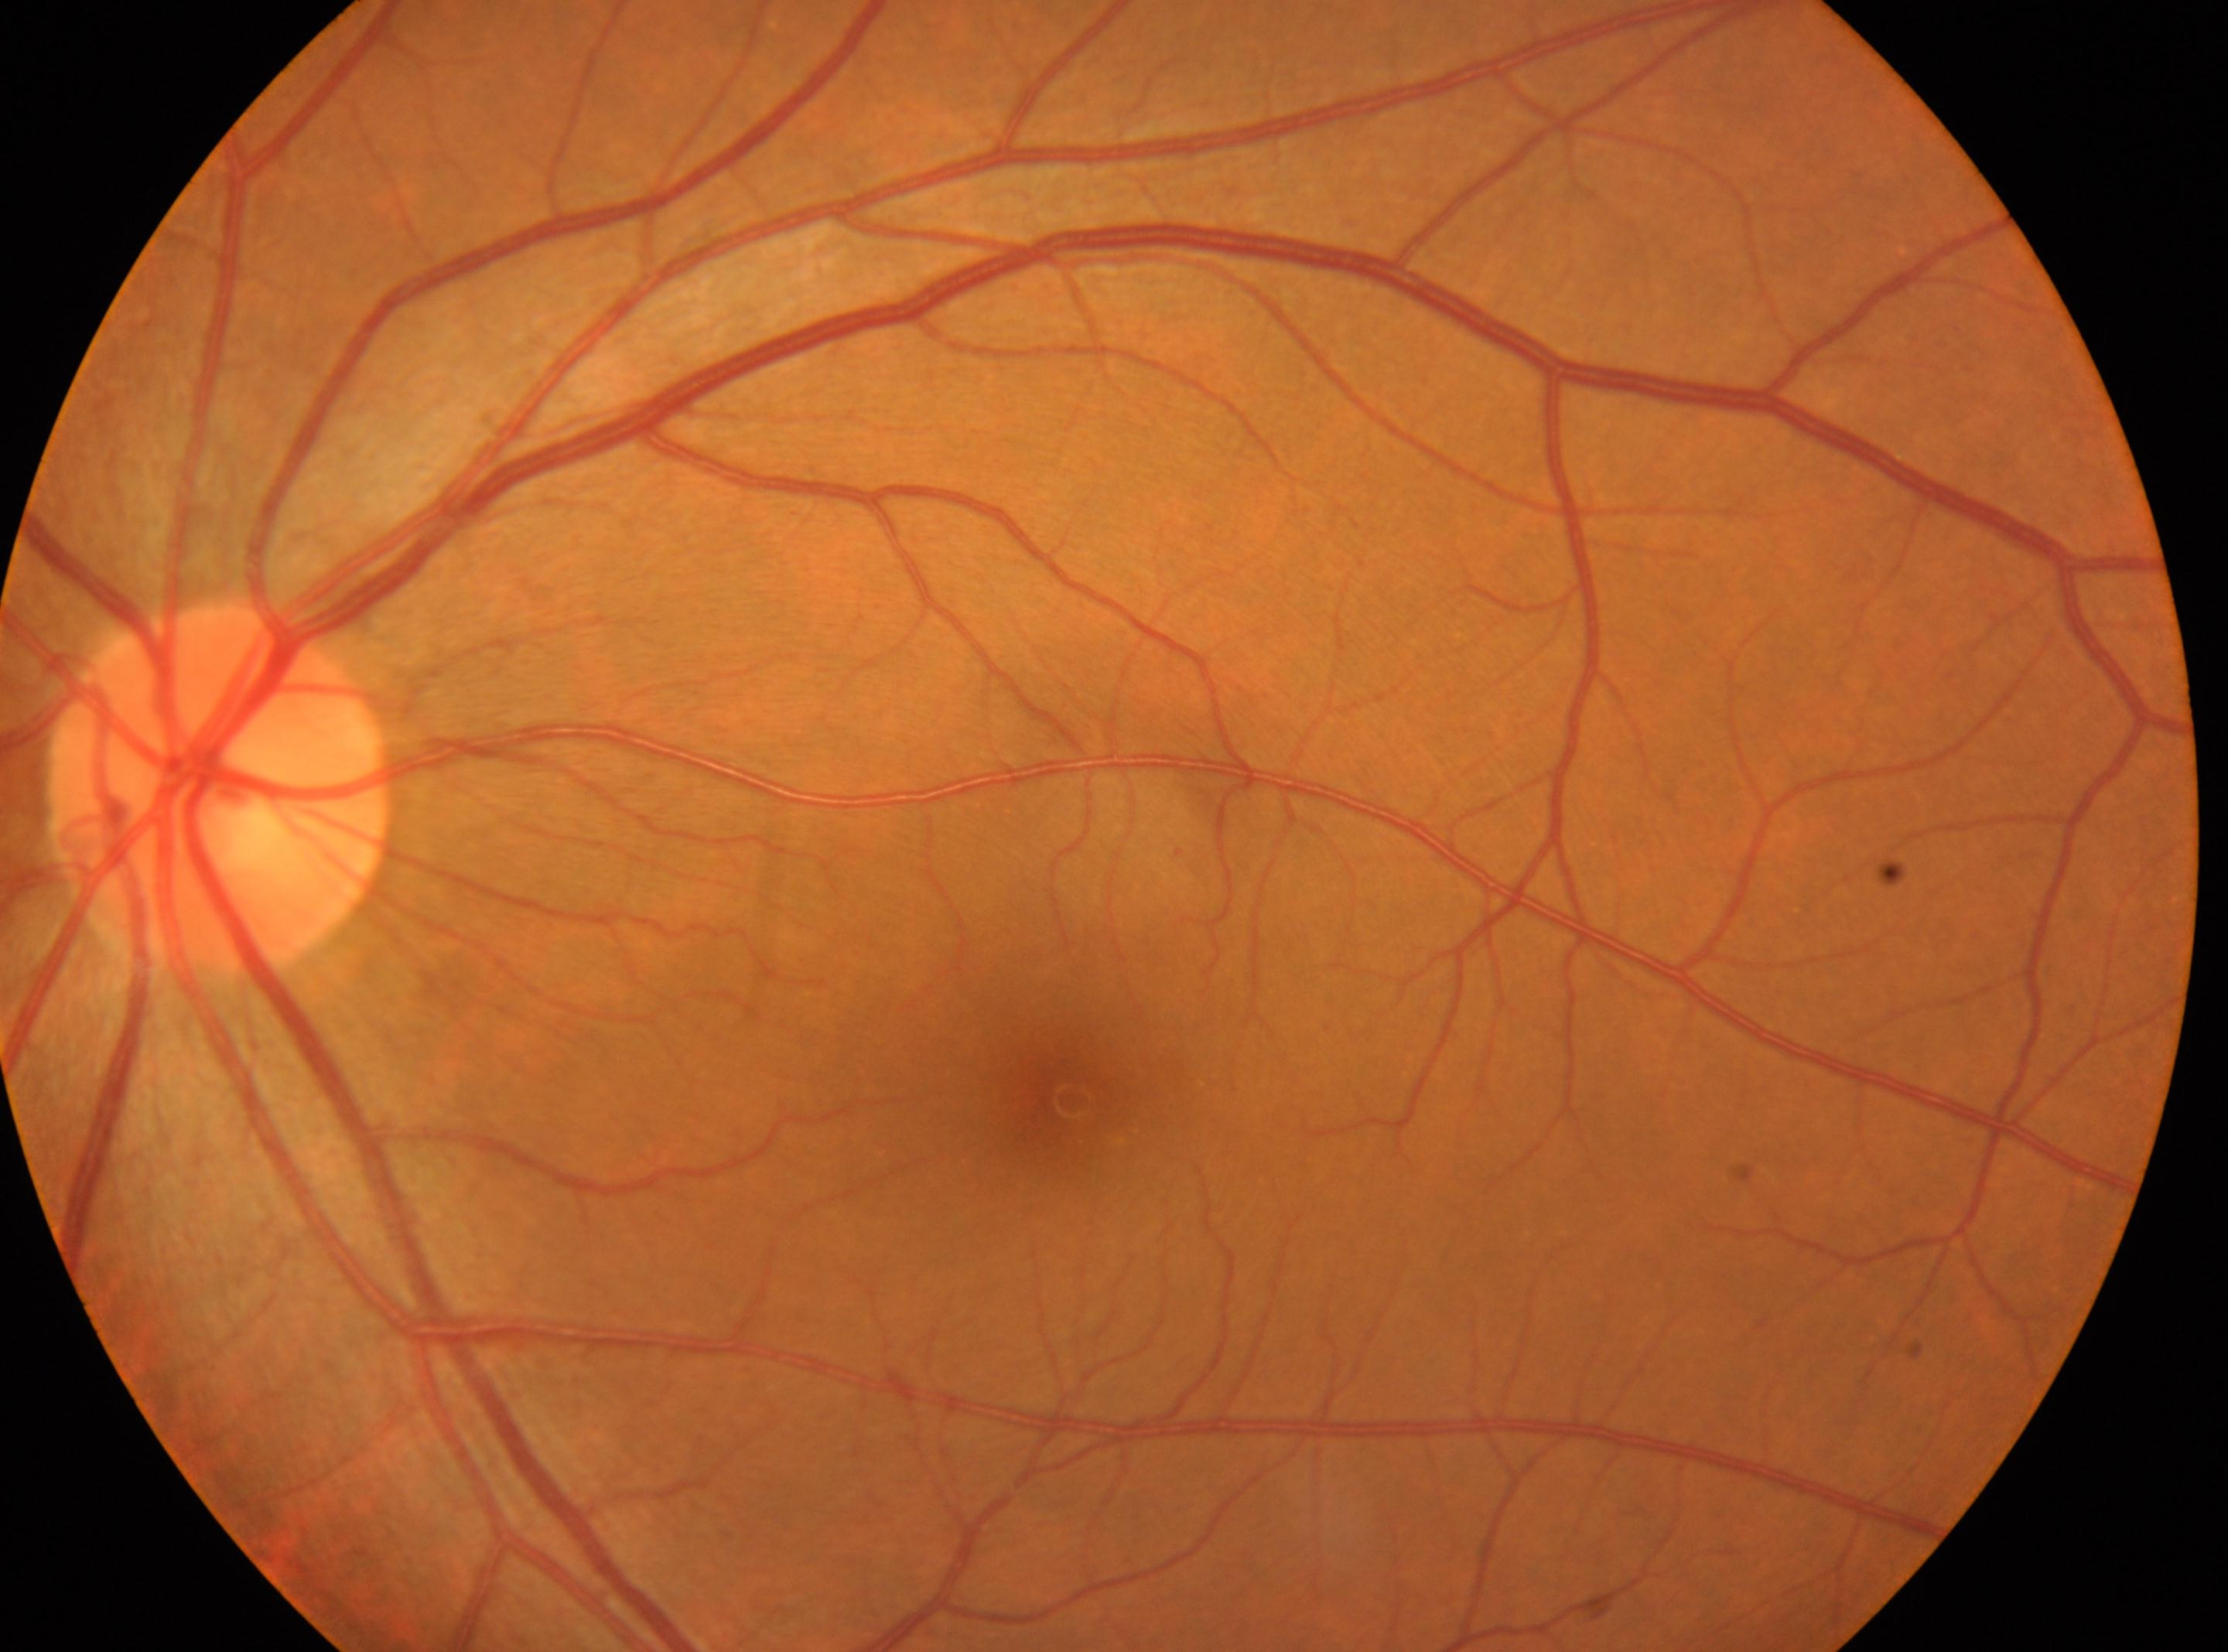 Findings:
- ONH — (x: 220, y: 787)
- eye — OS
- the fovea — (x: 1071, y: 1100)
- DR impression — No signs of diabetic retinopathy
- DR severity — 0 — no visible signs of diabetic retinopathy